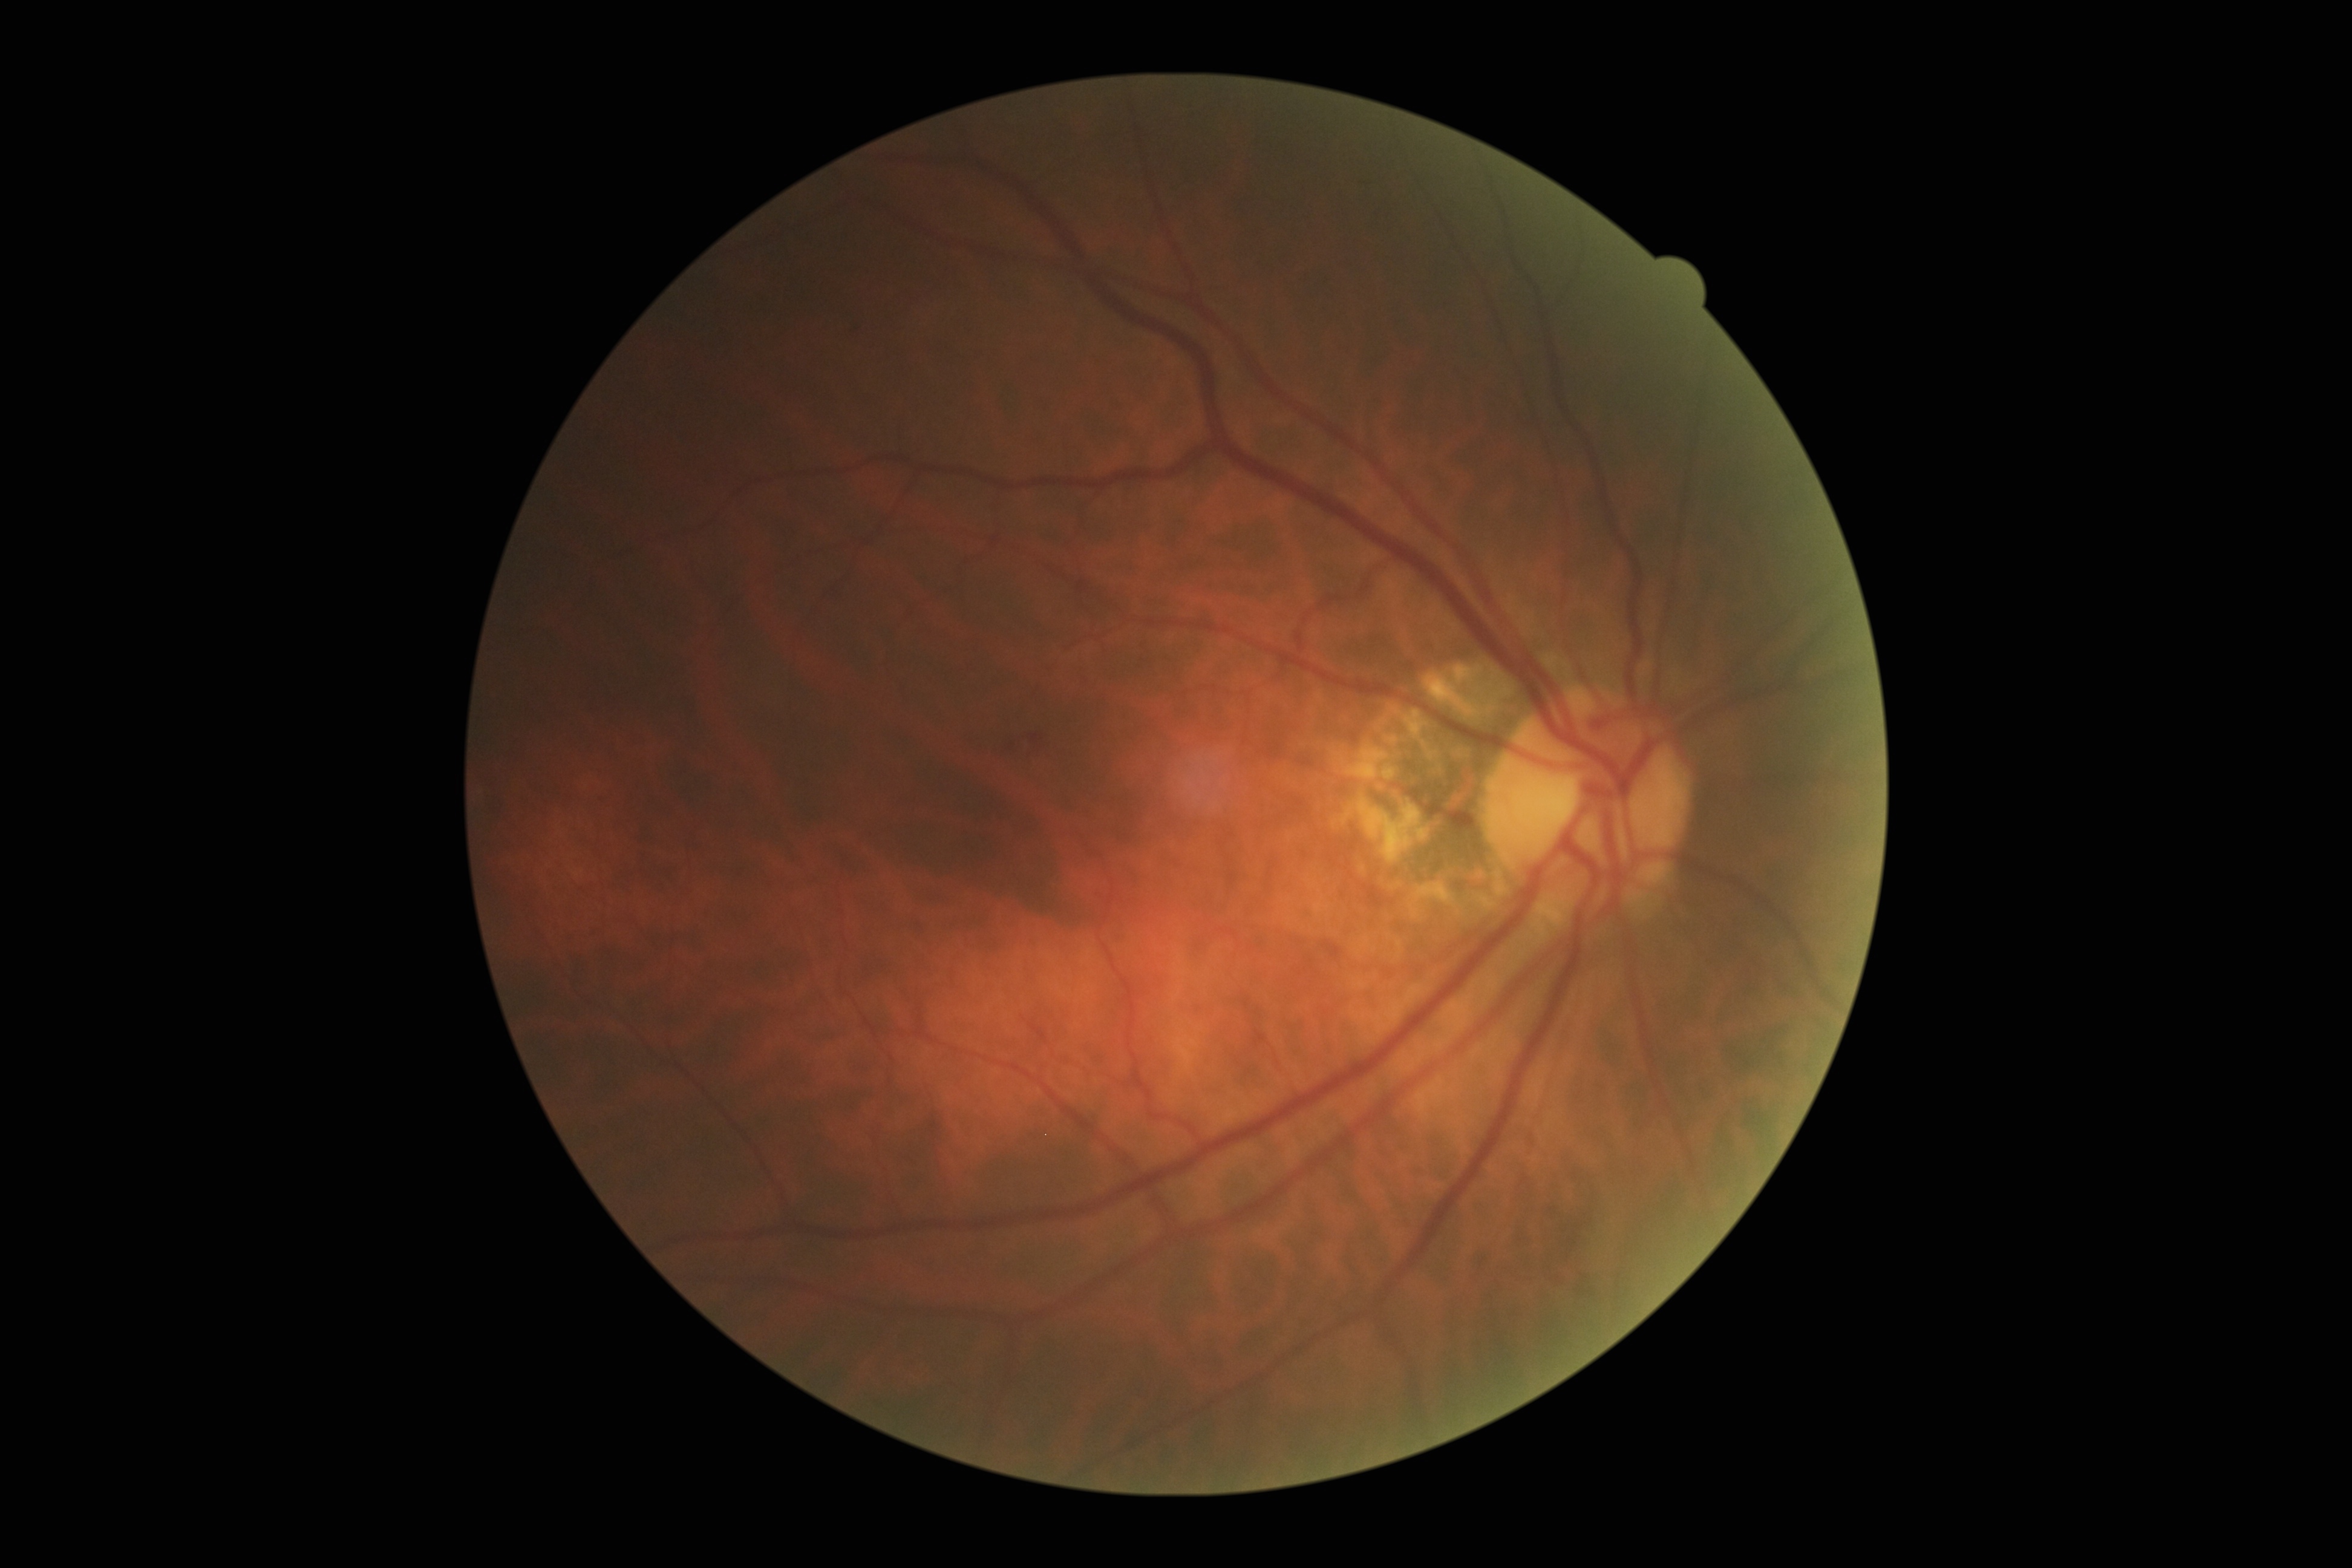

retinopathy grade = 2/4